Fundus photo.
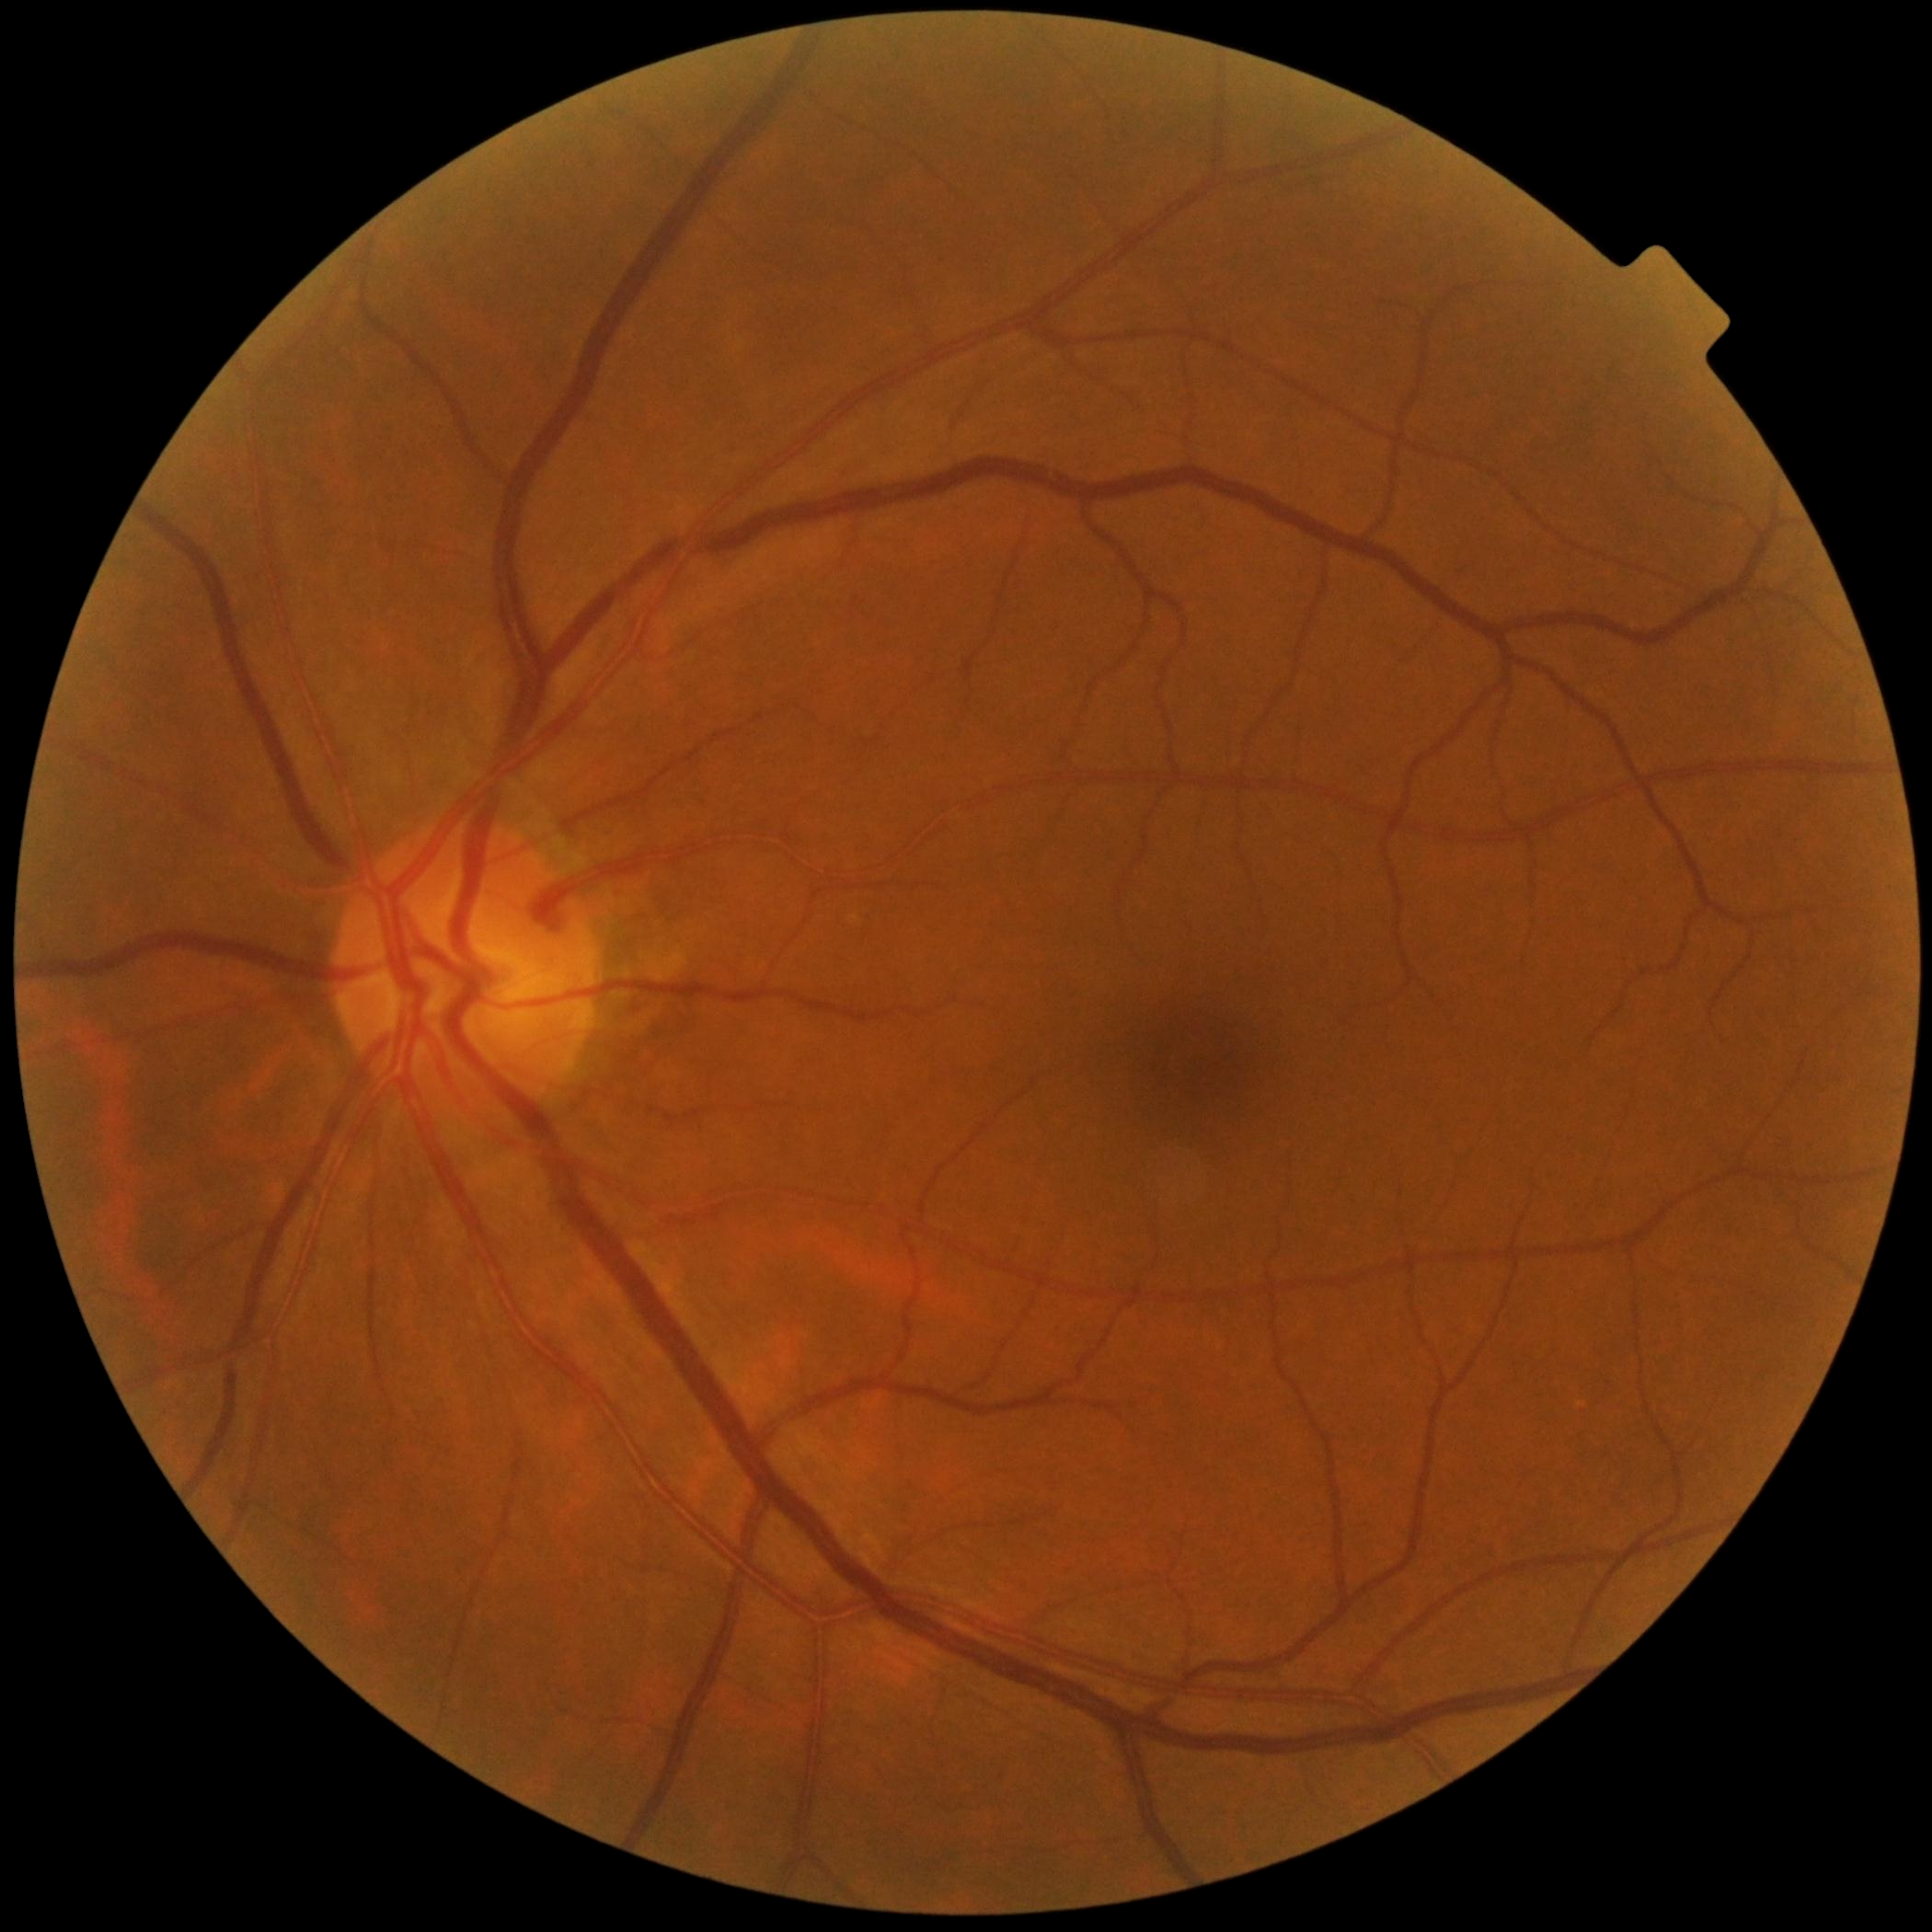 Diabetic retinopathy (DR) is grade 0 (no apparent retinopathy).